Modified Davis classification · posterior pole color fundus photograph · 45° FOV · without pupil dilation
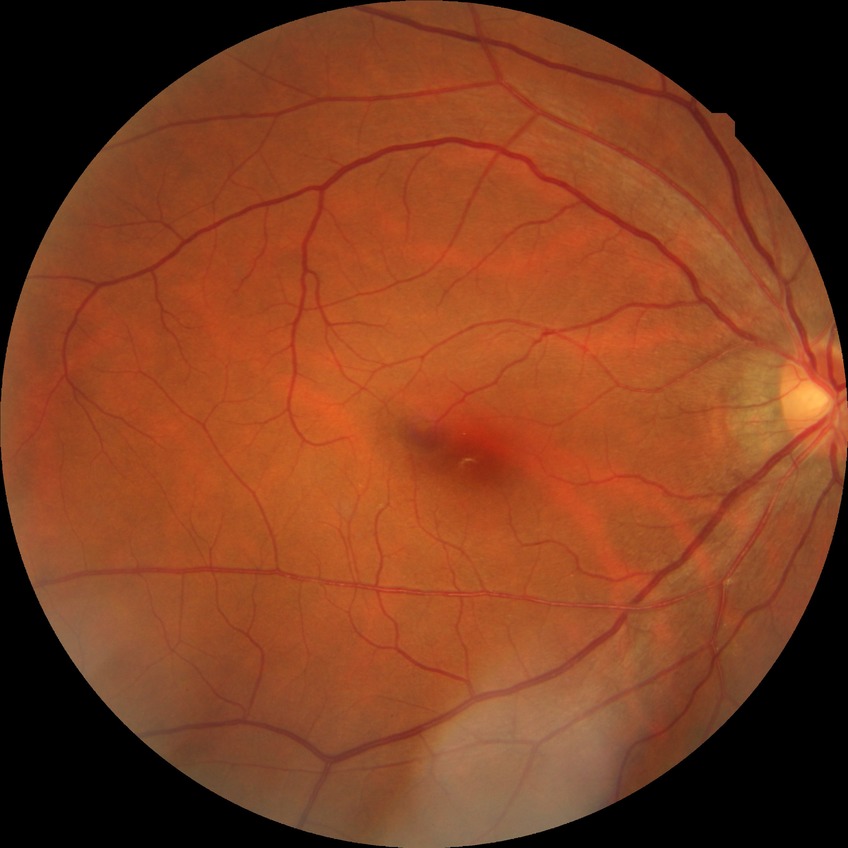
Assessment:
• diabetic retinopathy stage — no diabetic retinopathy